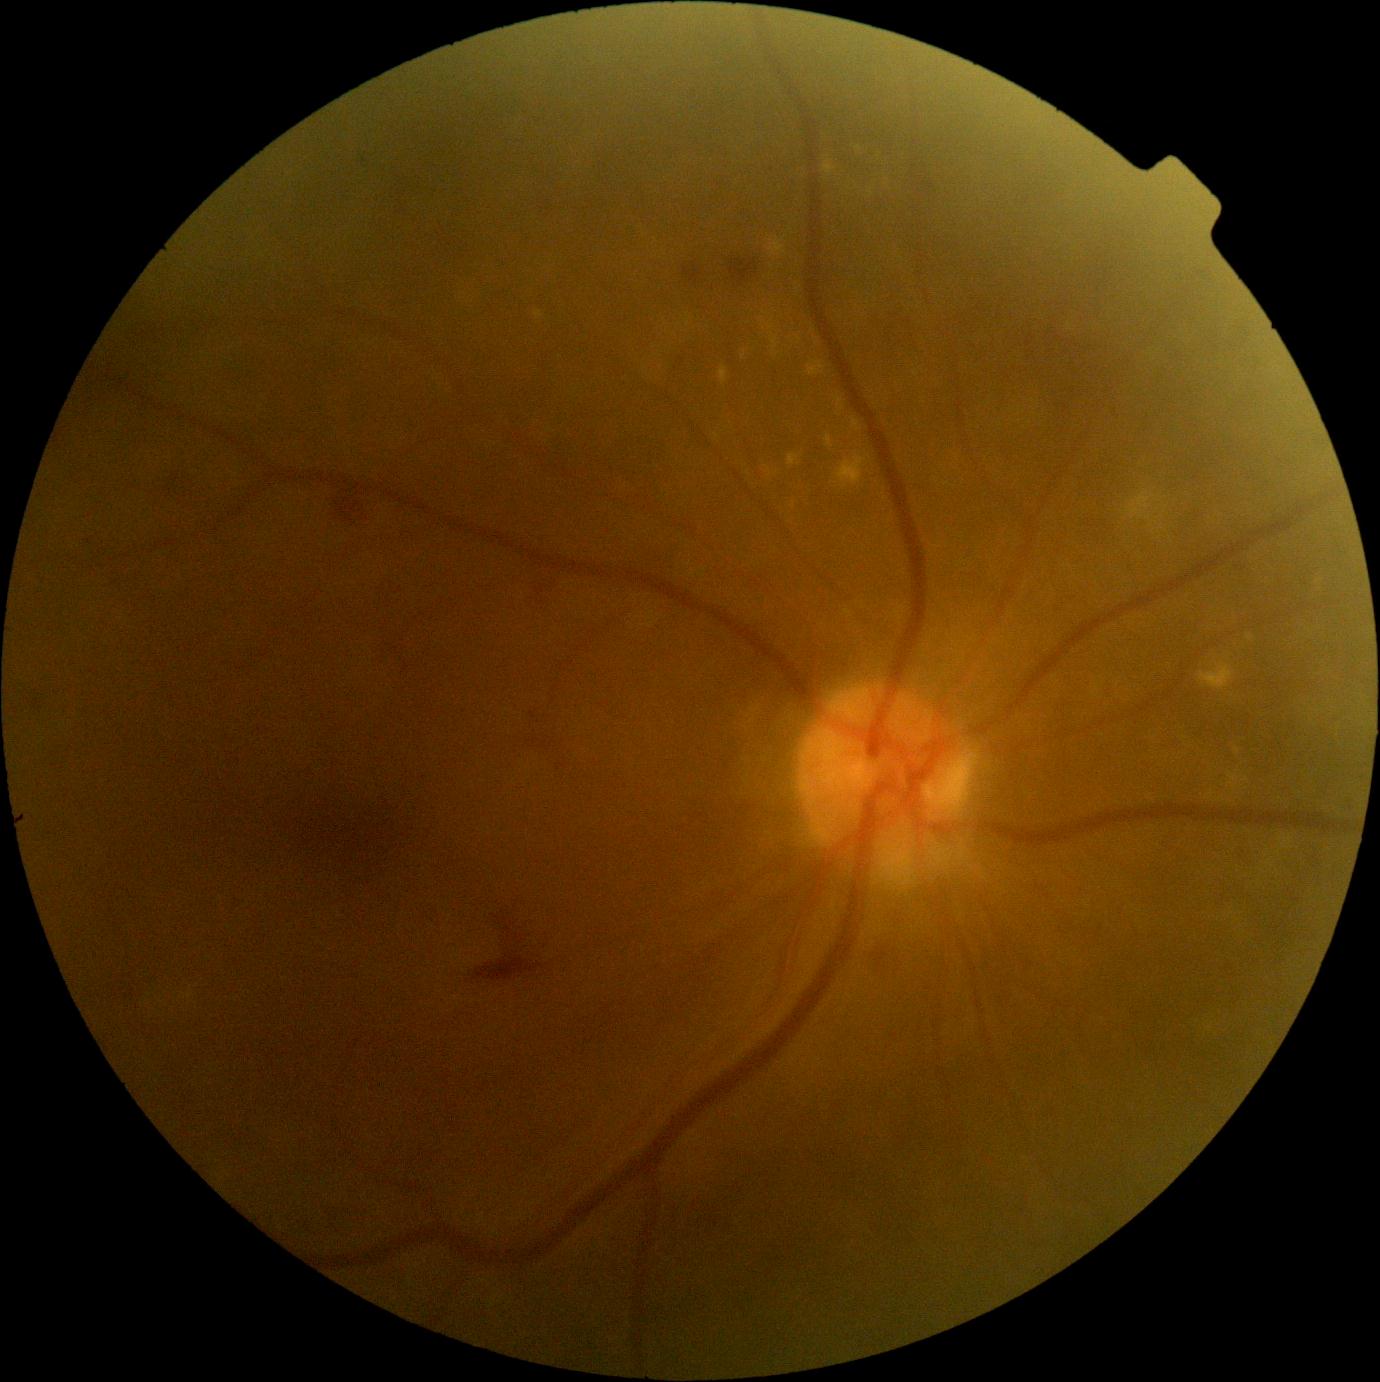 Retinopathy grade: 2. Hard exudates are present, including at box(836, 397, 845, 411); box(719, 367, 728, 385); box(823, 161, 836, 176); box(1199, 663, 1234, 690); box(825, 436, 834, 448); box(741, 351, 747, 359); box(763, 312, 771, 316); box(788, 454, 801, 467); box(767, 238, 787, 258). Small hard exudates near [x=772, y=321]; [x=812, y=330]; [x=718, y=437]; [x=1237, y=751].